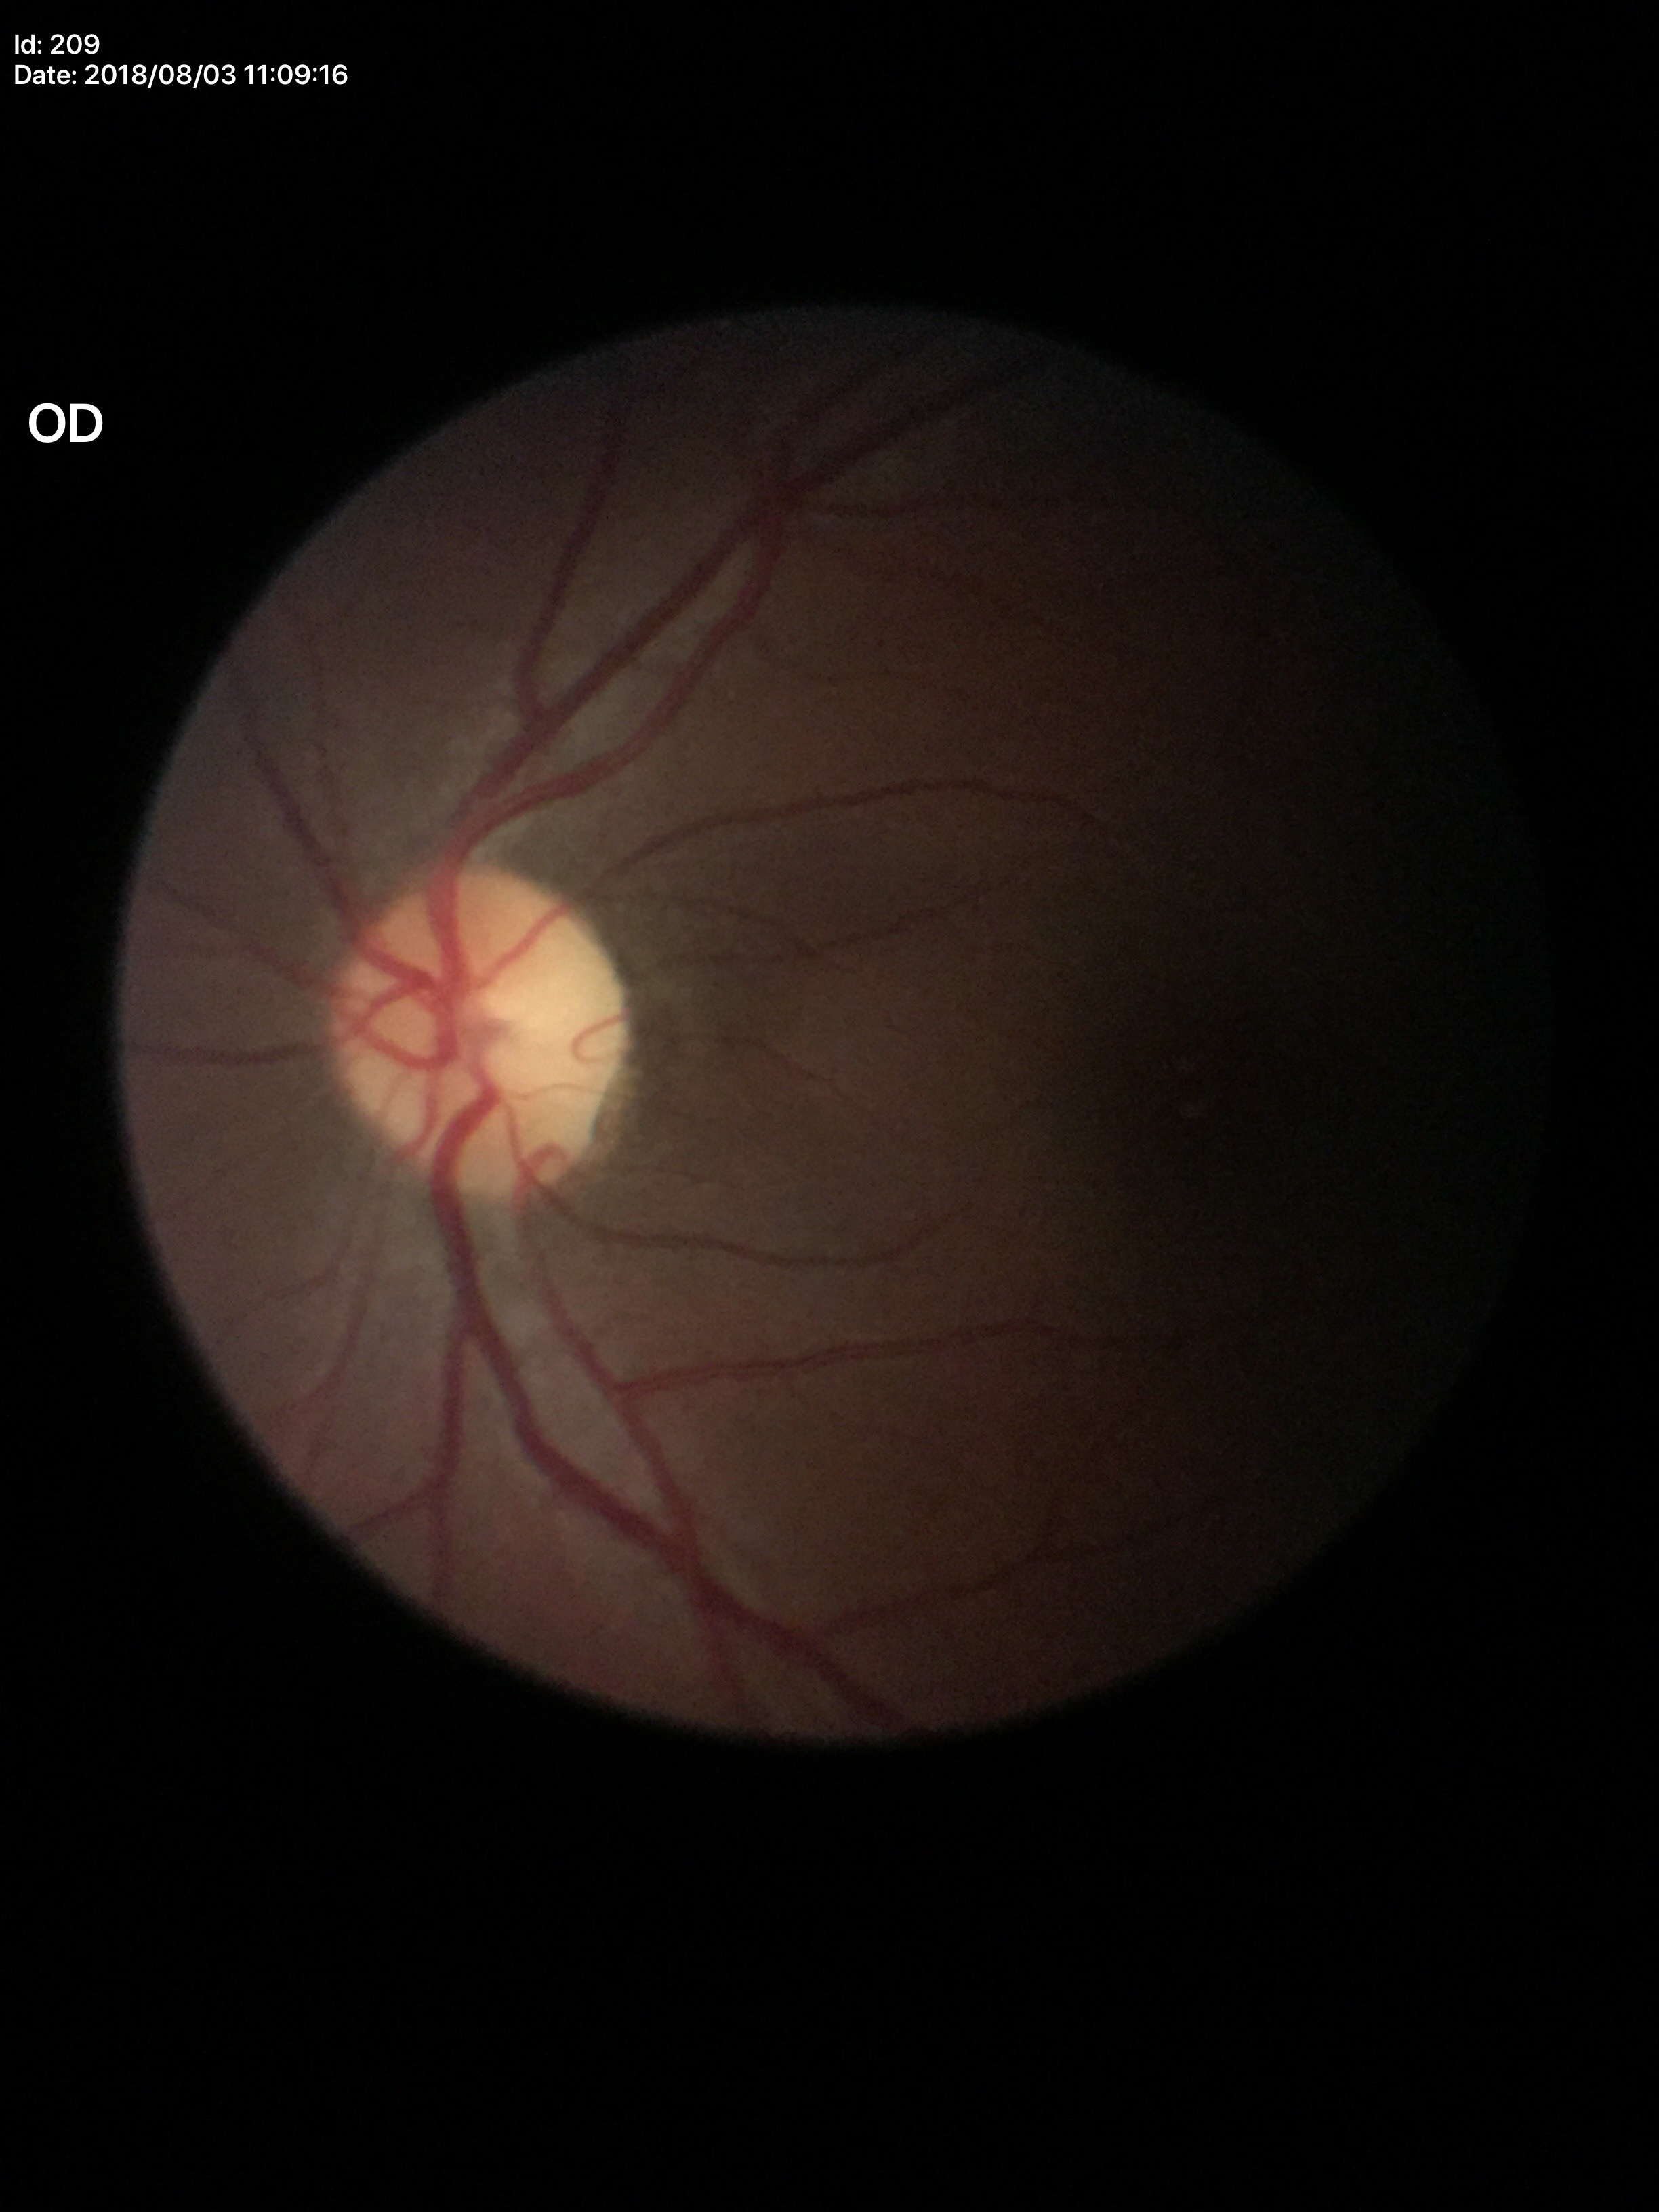 Vertical cup-to-disc ratio (VCDR) of 0.44.
No glaucomatous findings.